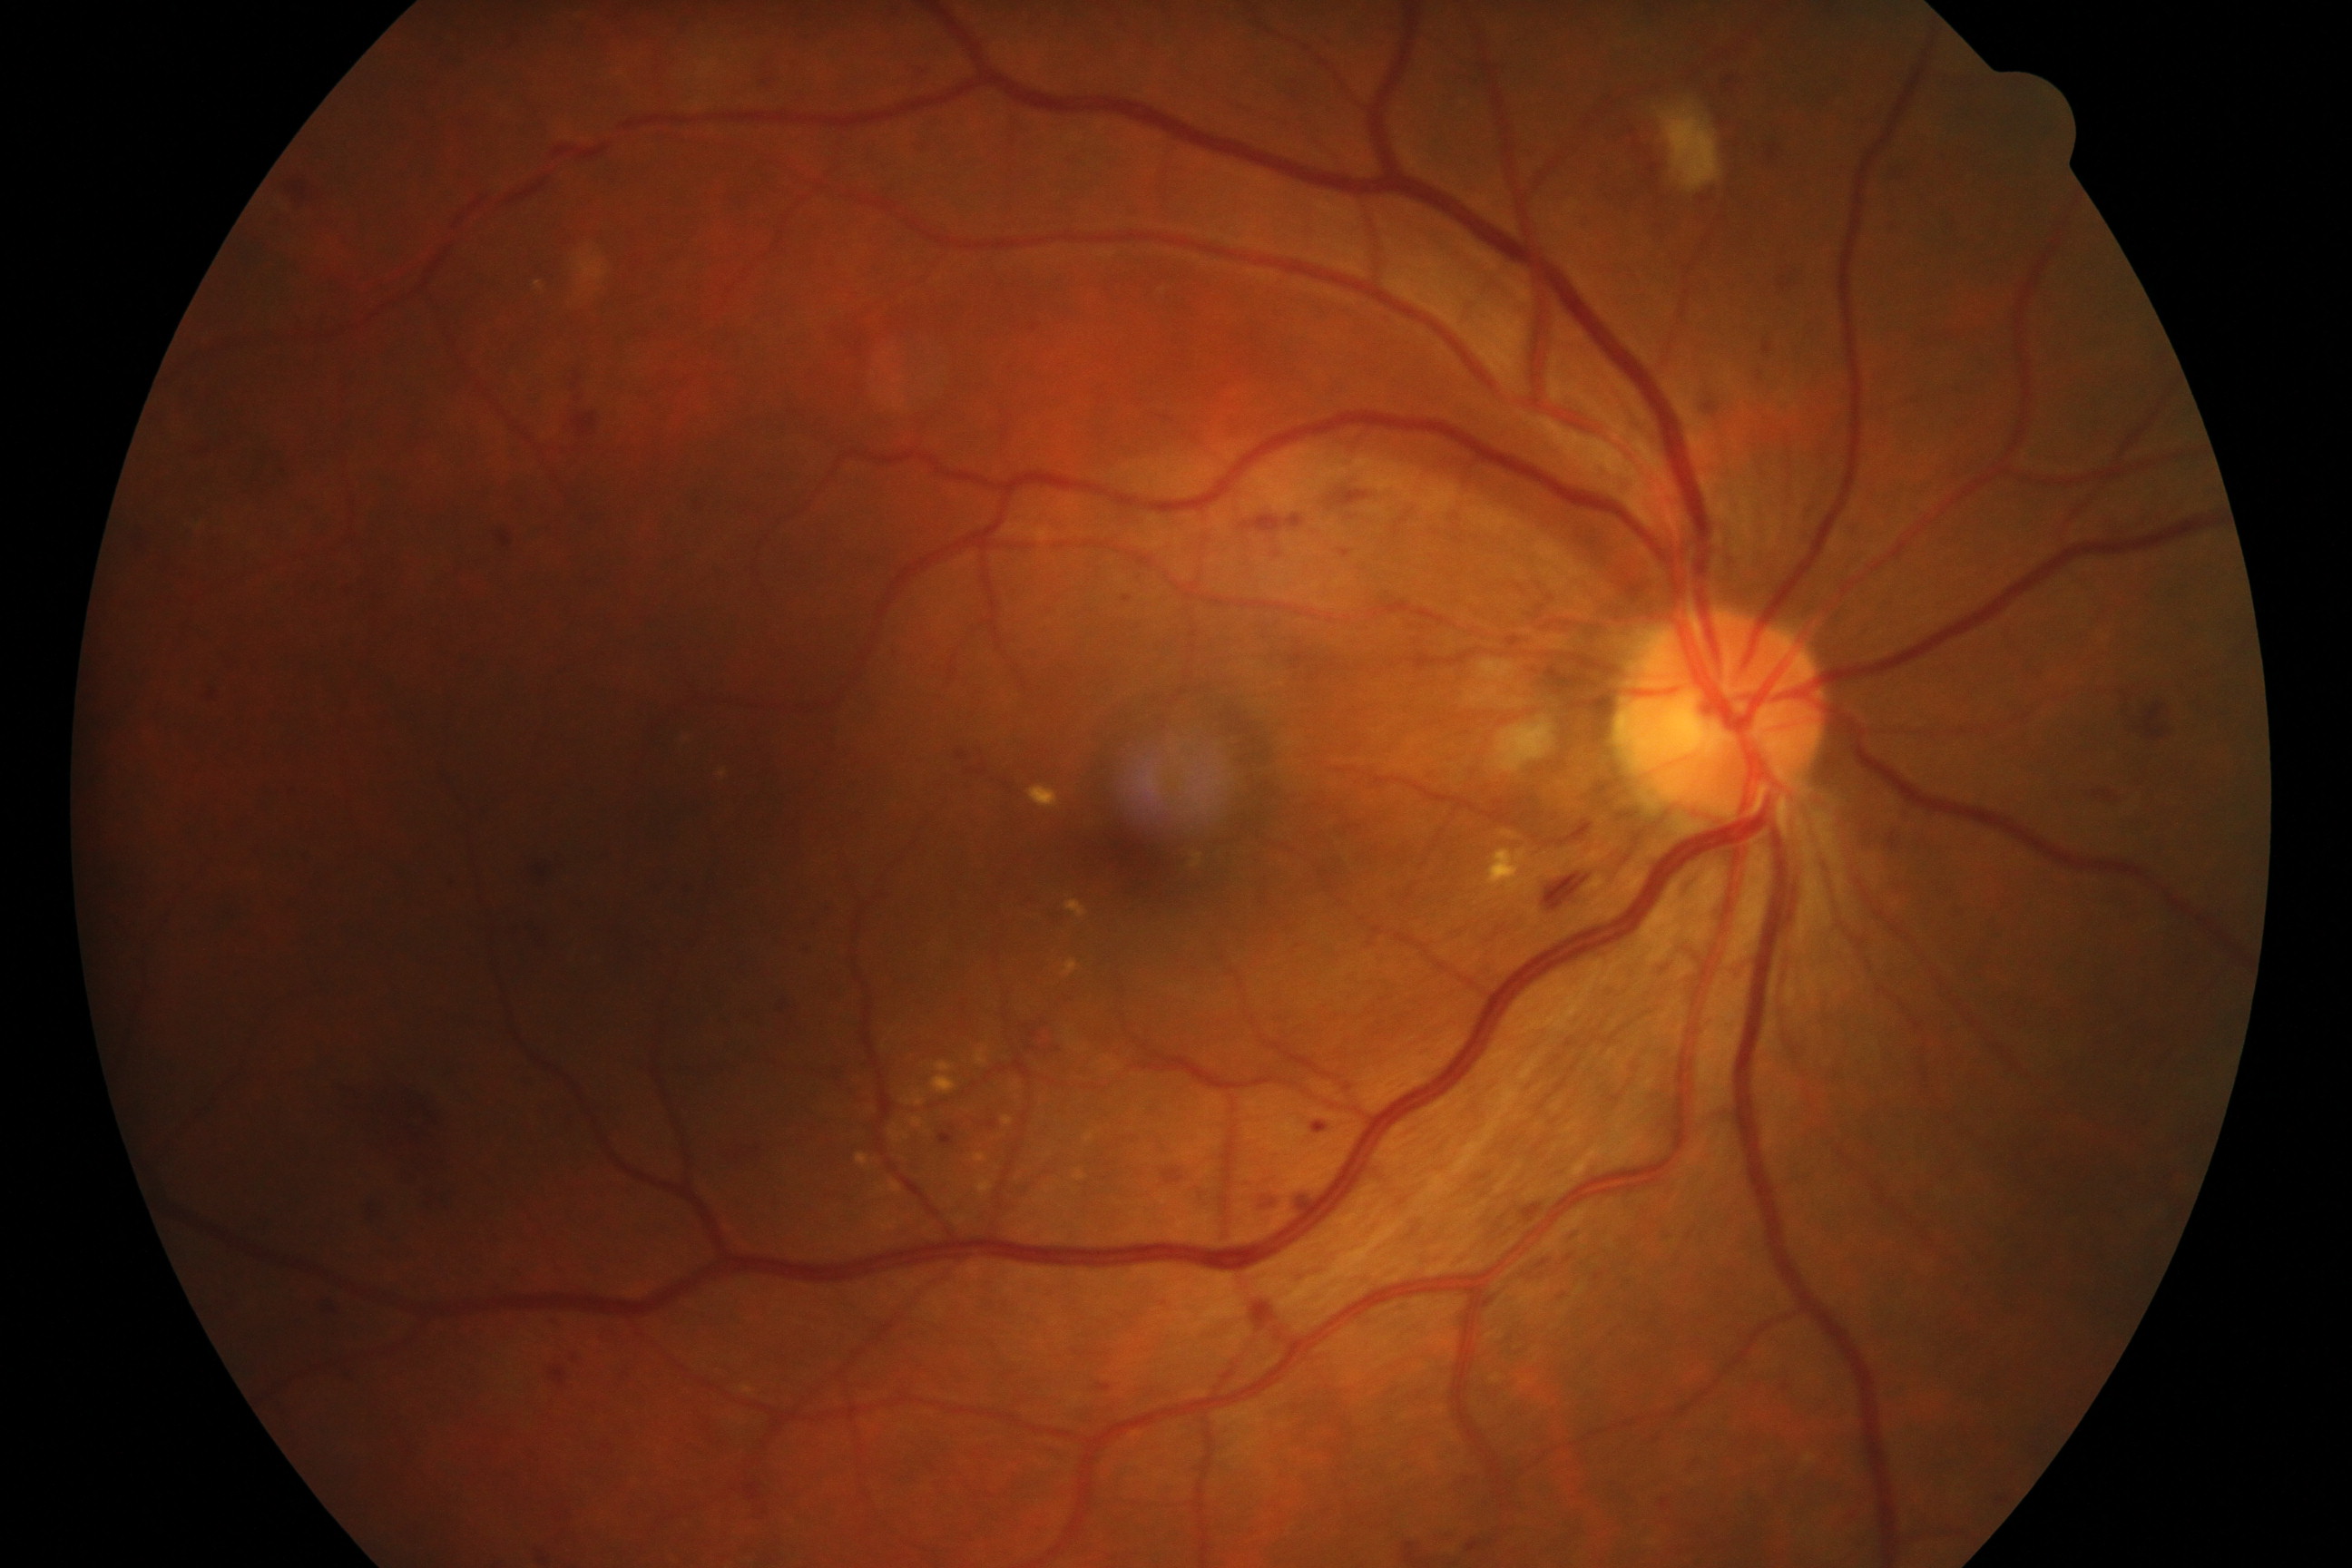

Appearance consistent with moderate non-proliferative diabetic retinopathy.